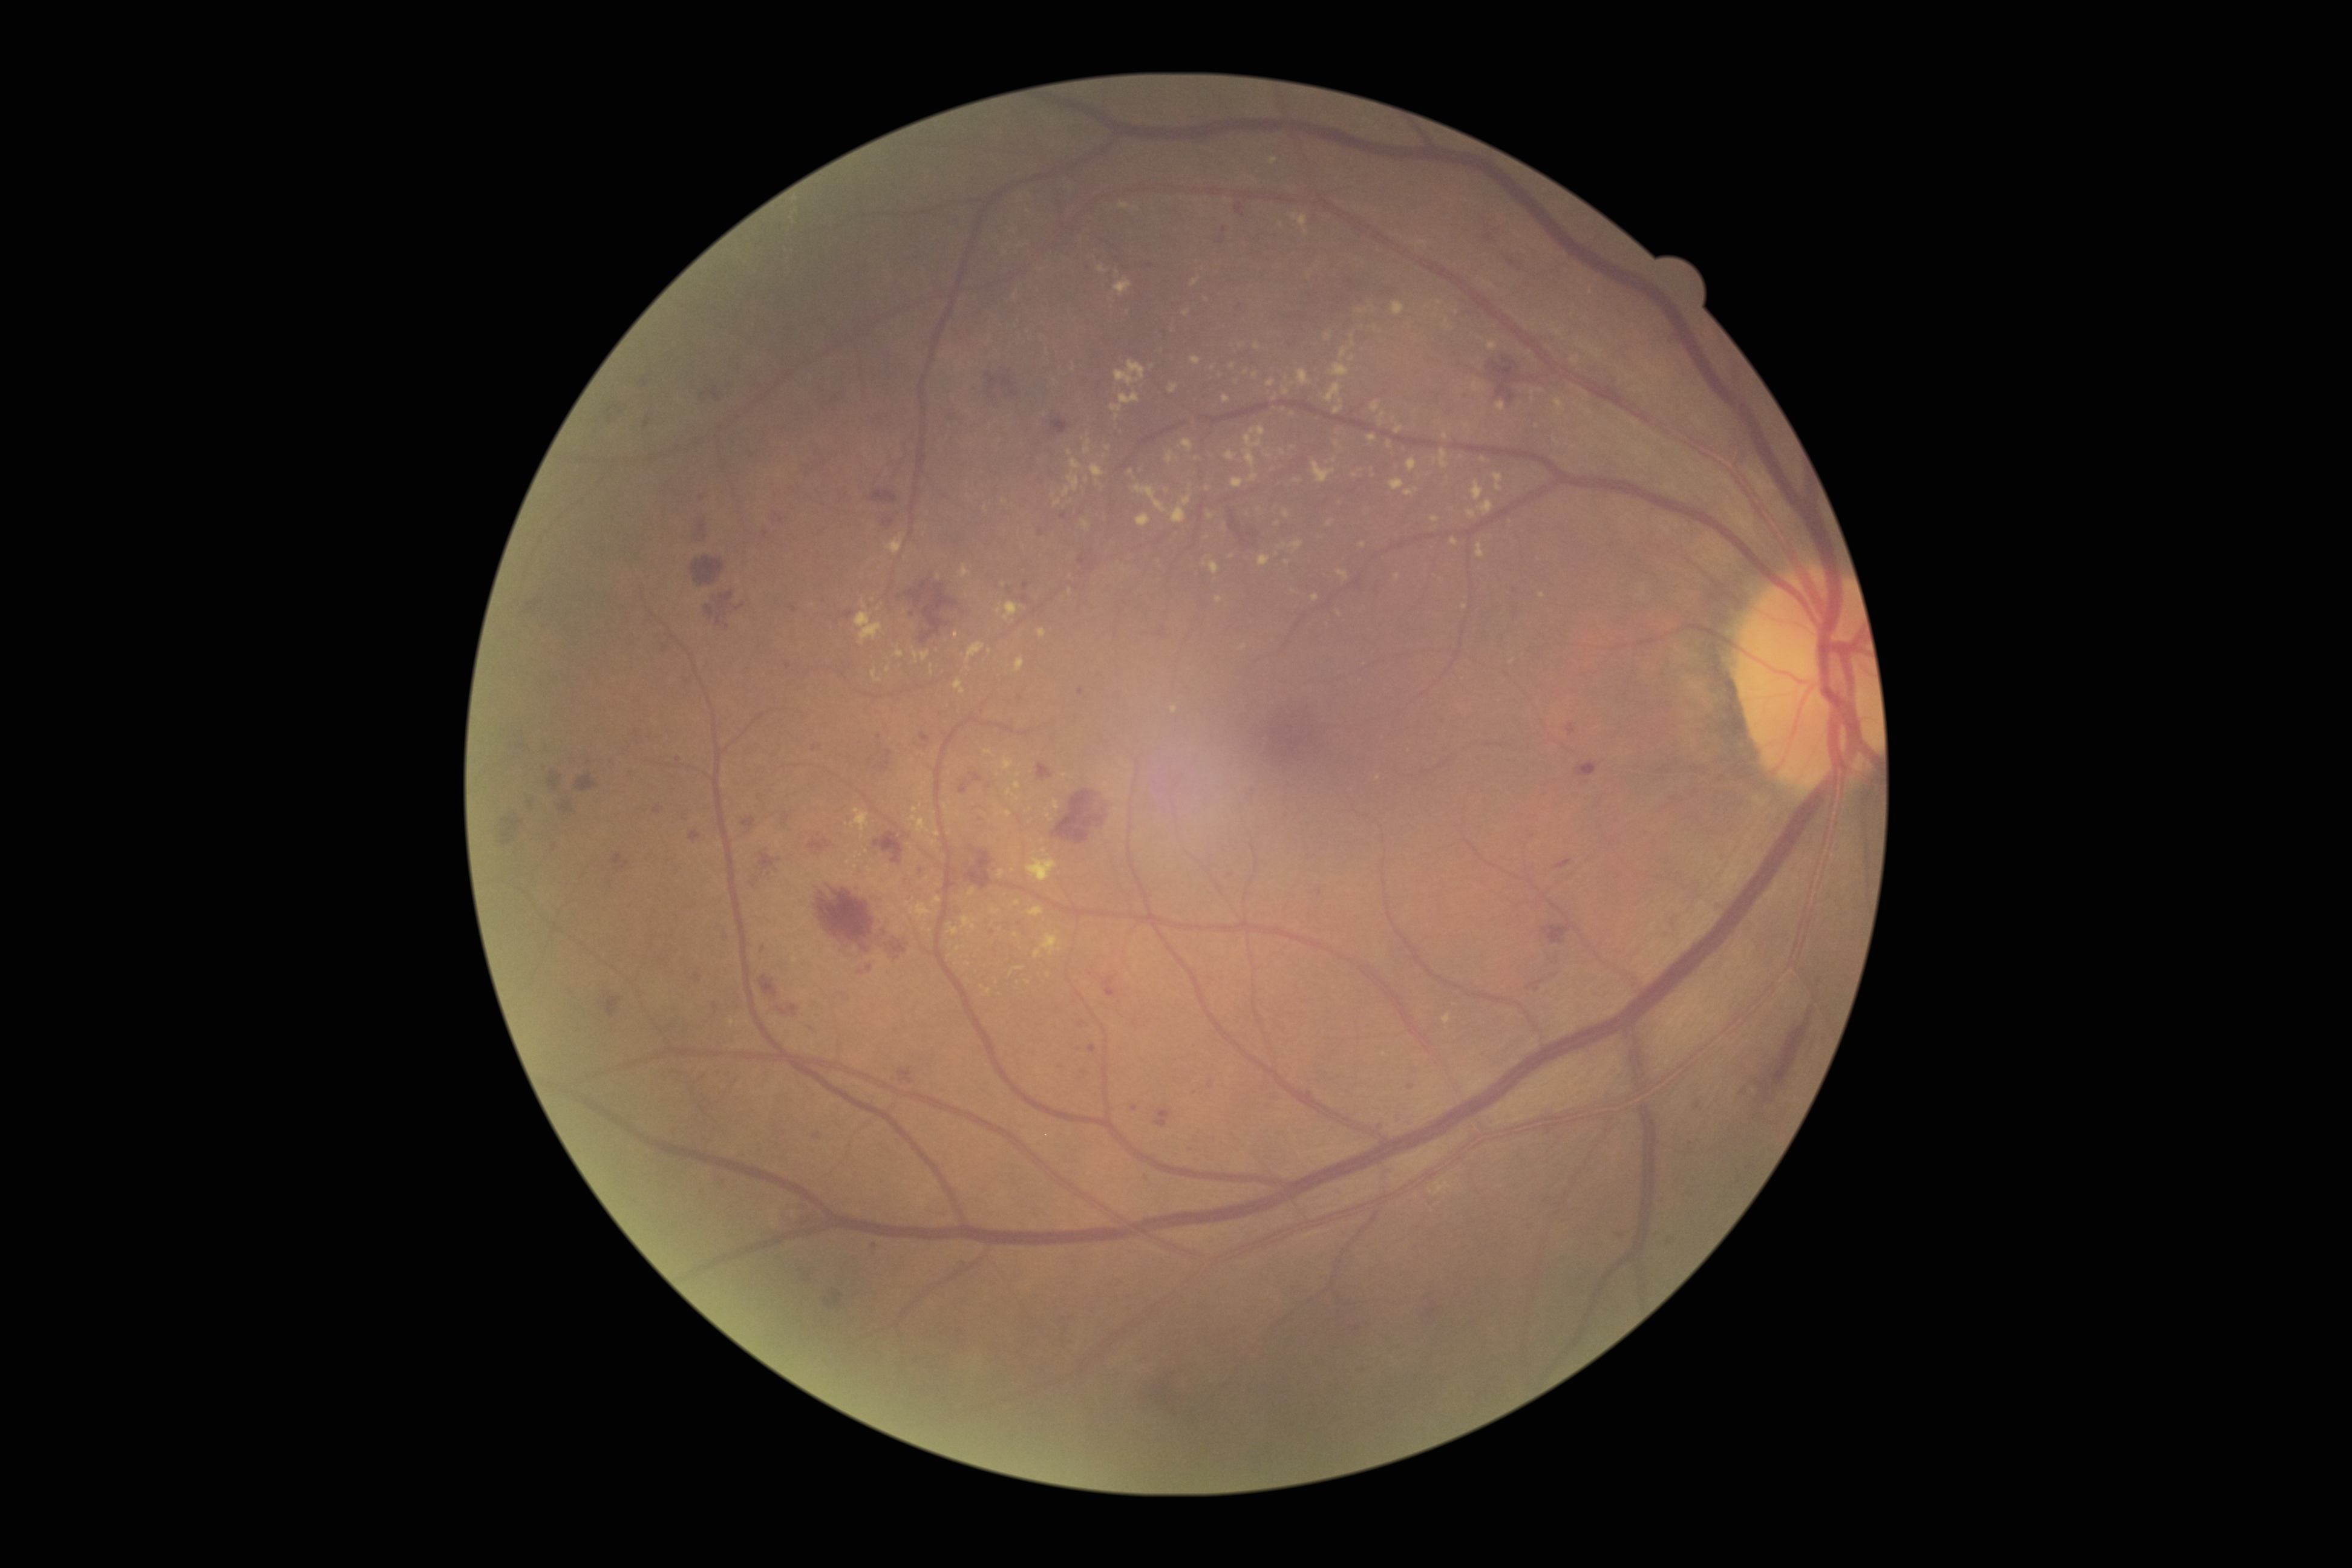

DR stage is 3.